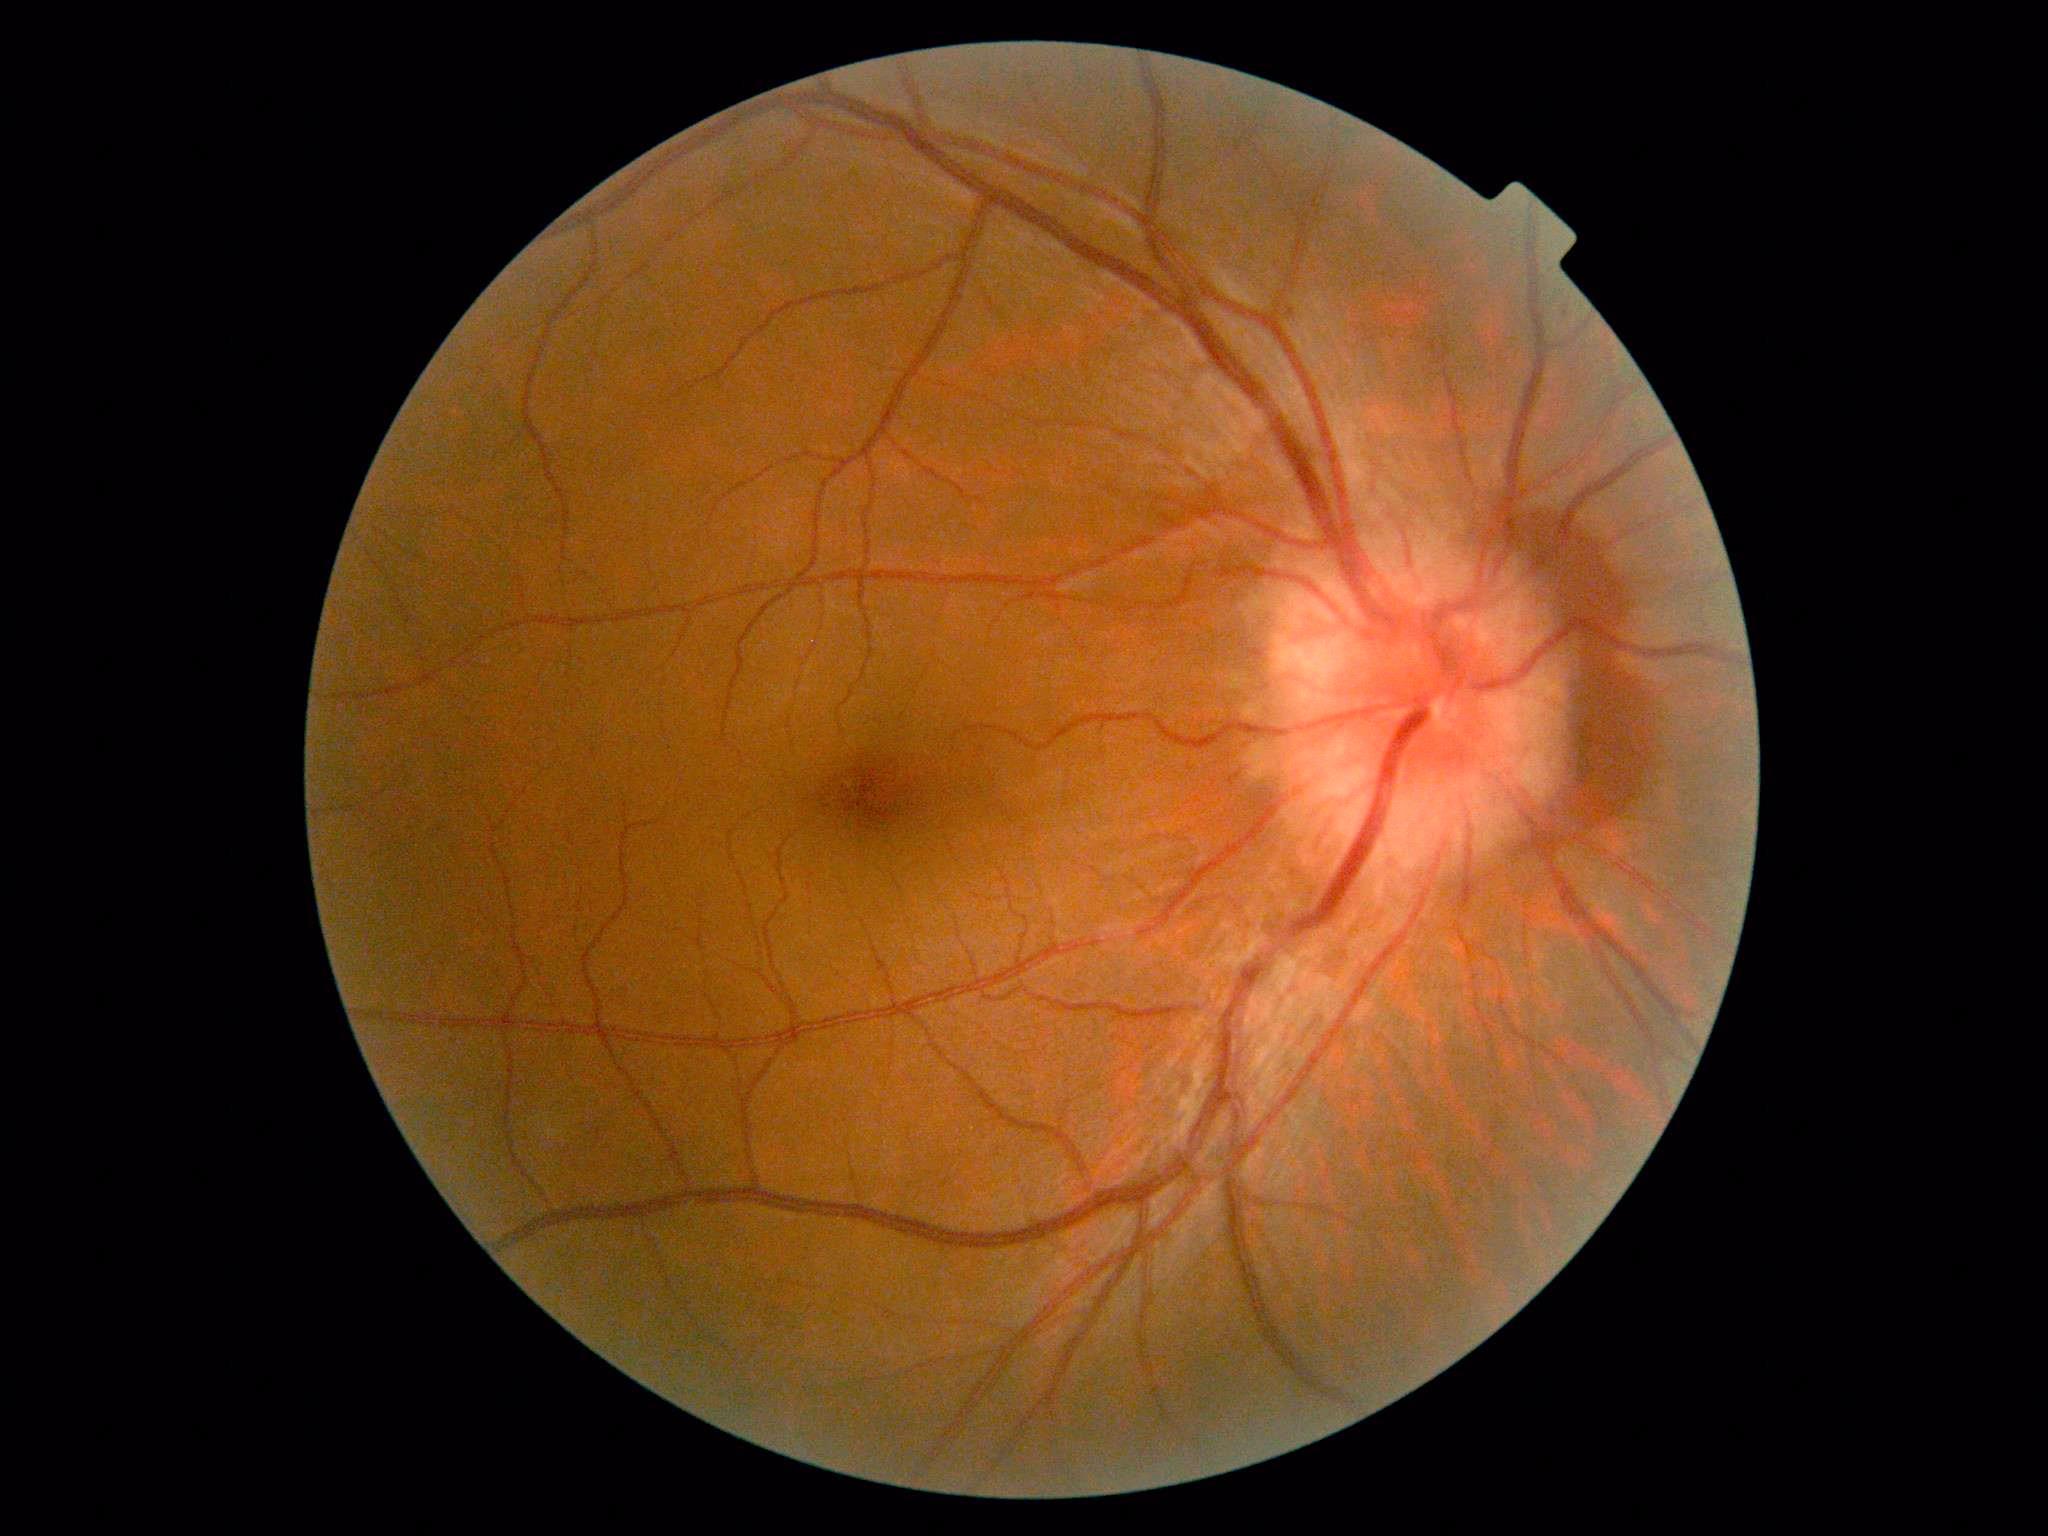
DR severity: 4 — neovascularization and/or vitreous/pre-retinal hemorrhage.